Color fundus photograph: 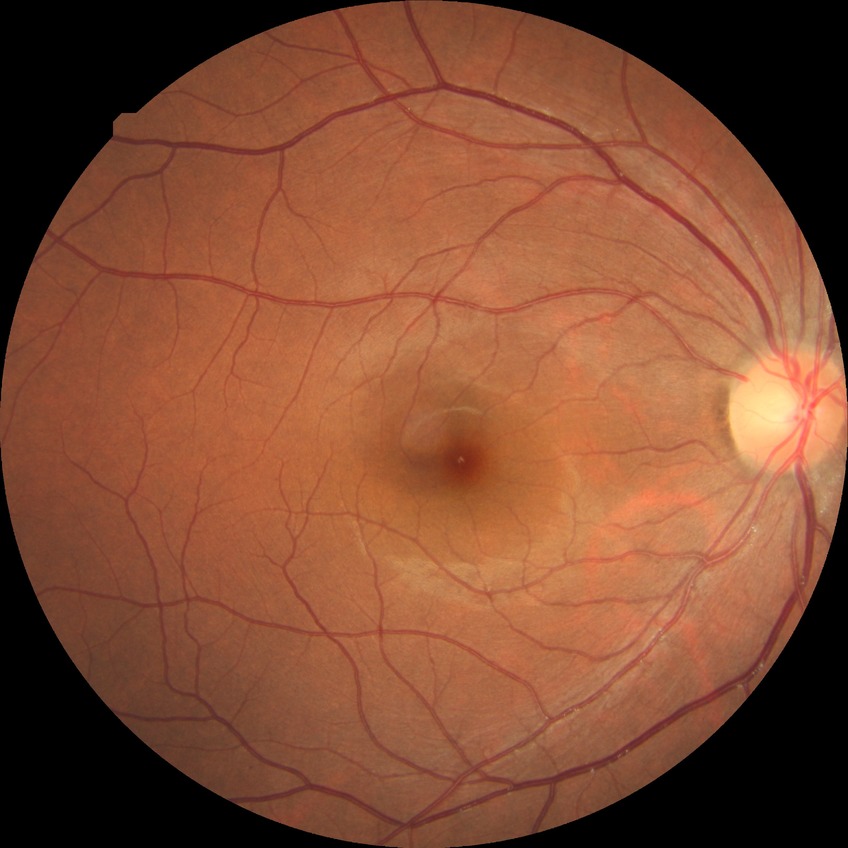
Diabetic retinopathy (DR) is no diabetic retinopathy (NDR).